Graded on the modified Davis scale, NIDEK AFC-230
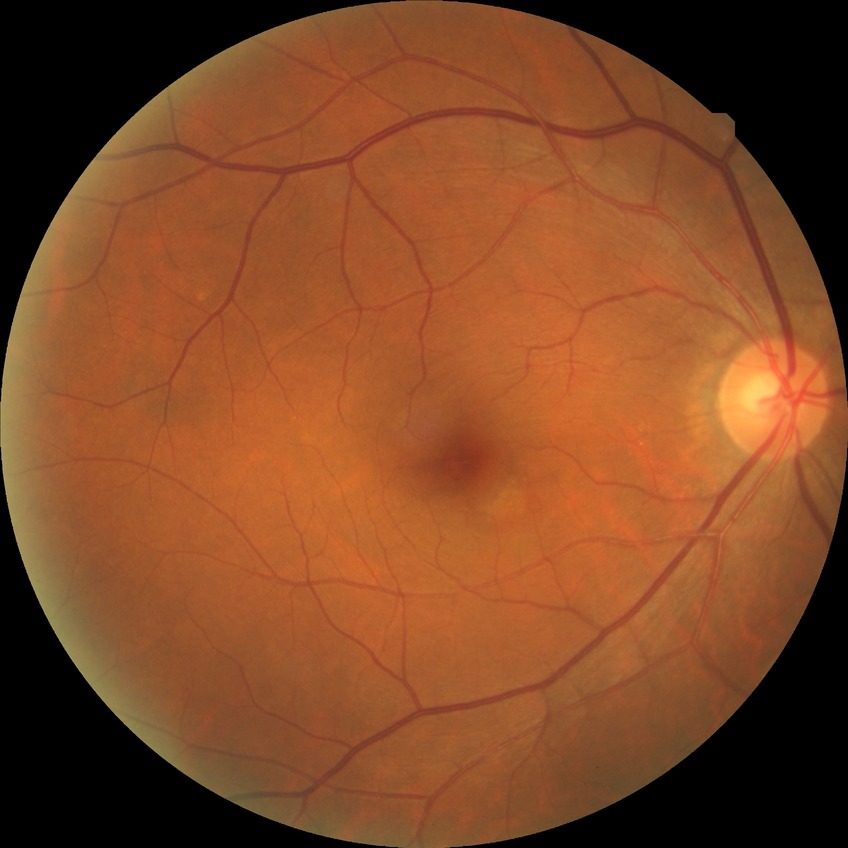

No signs of diabetic retinopathy. DR severity is NDR.